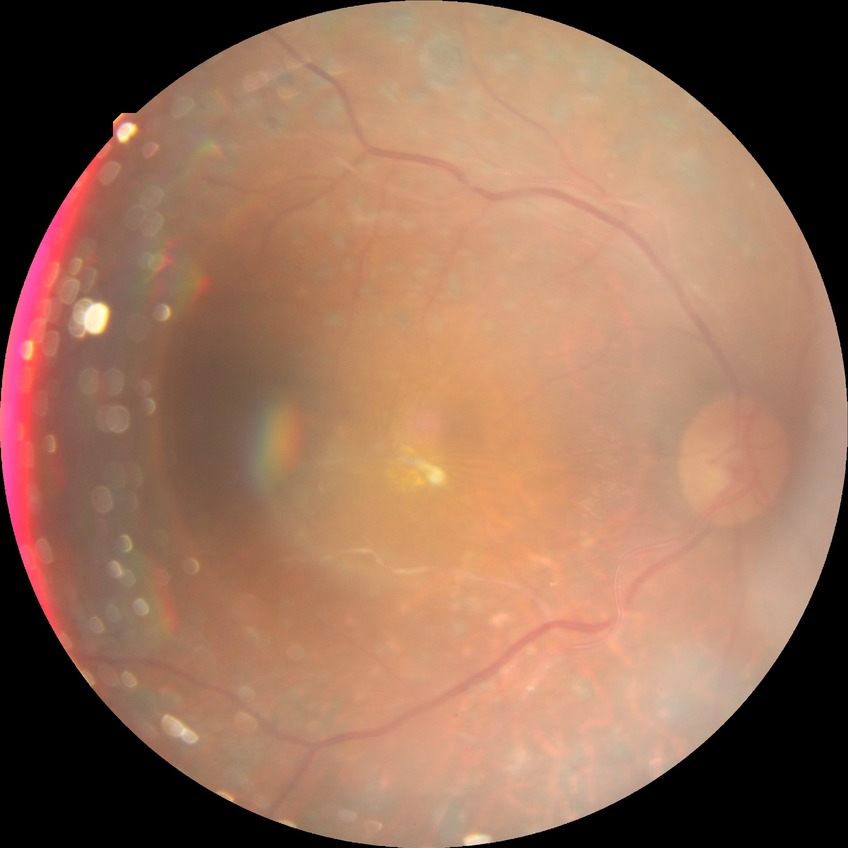
Diabetic retinopathy grade is proliferative diabetic retinopathy.